Graded on the modified Davis scale, 45° FOV, posterior pole color fundus photograph.
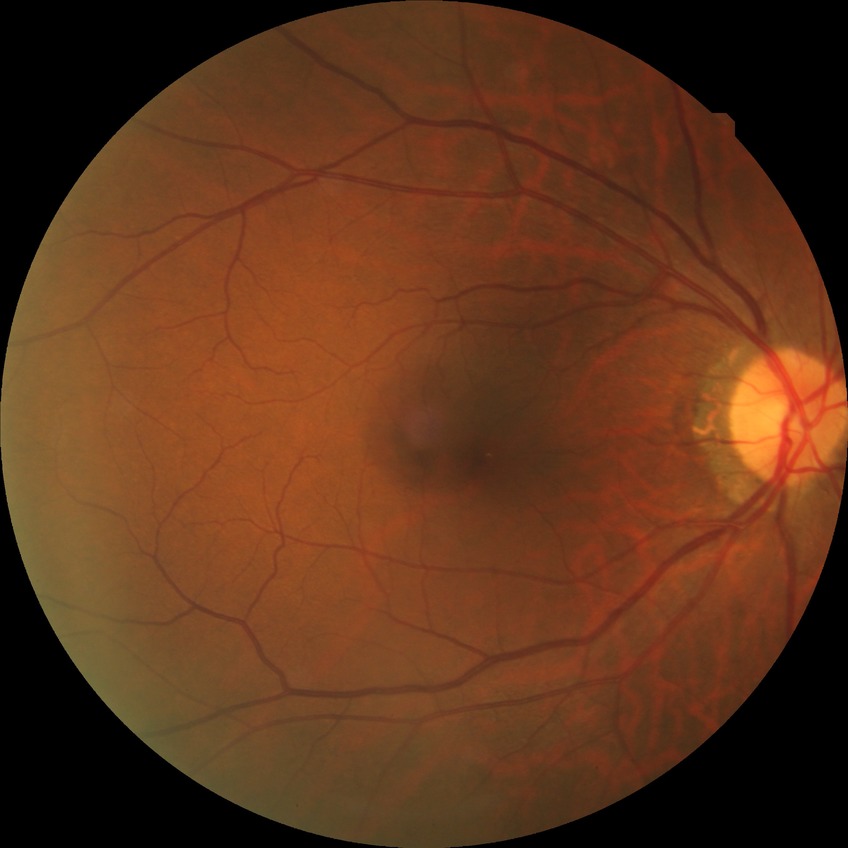 diabetic retinopathy (DR) = NDR (no diabetic retinopathy).